CFP. FOV: 45 degrees — 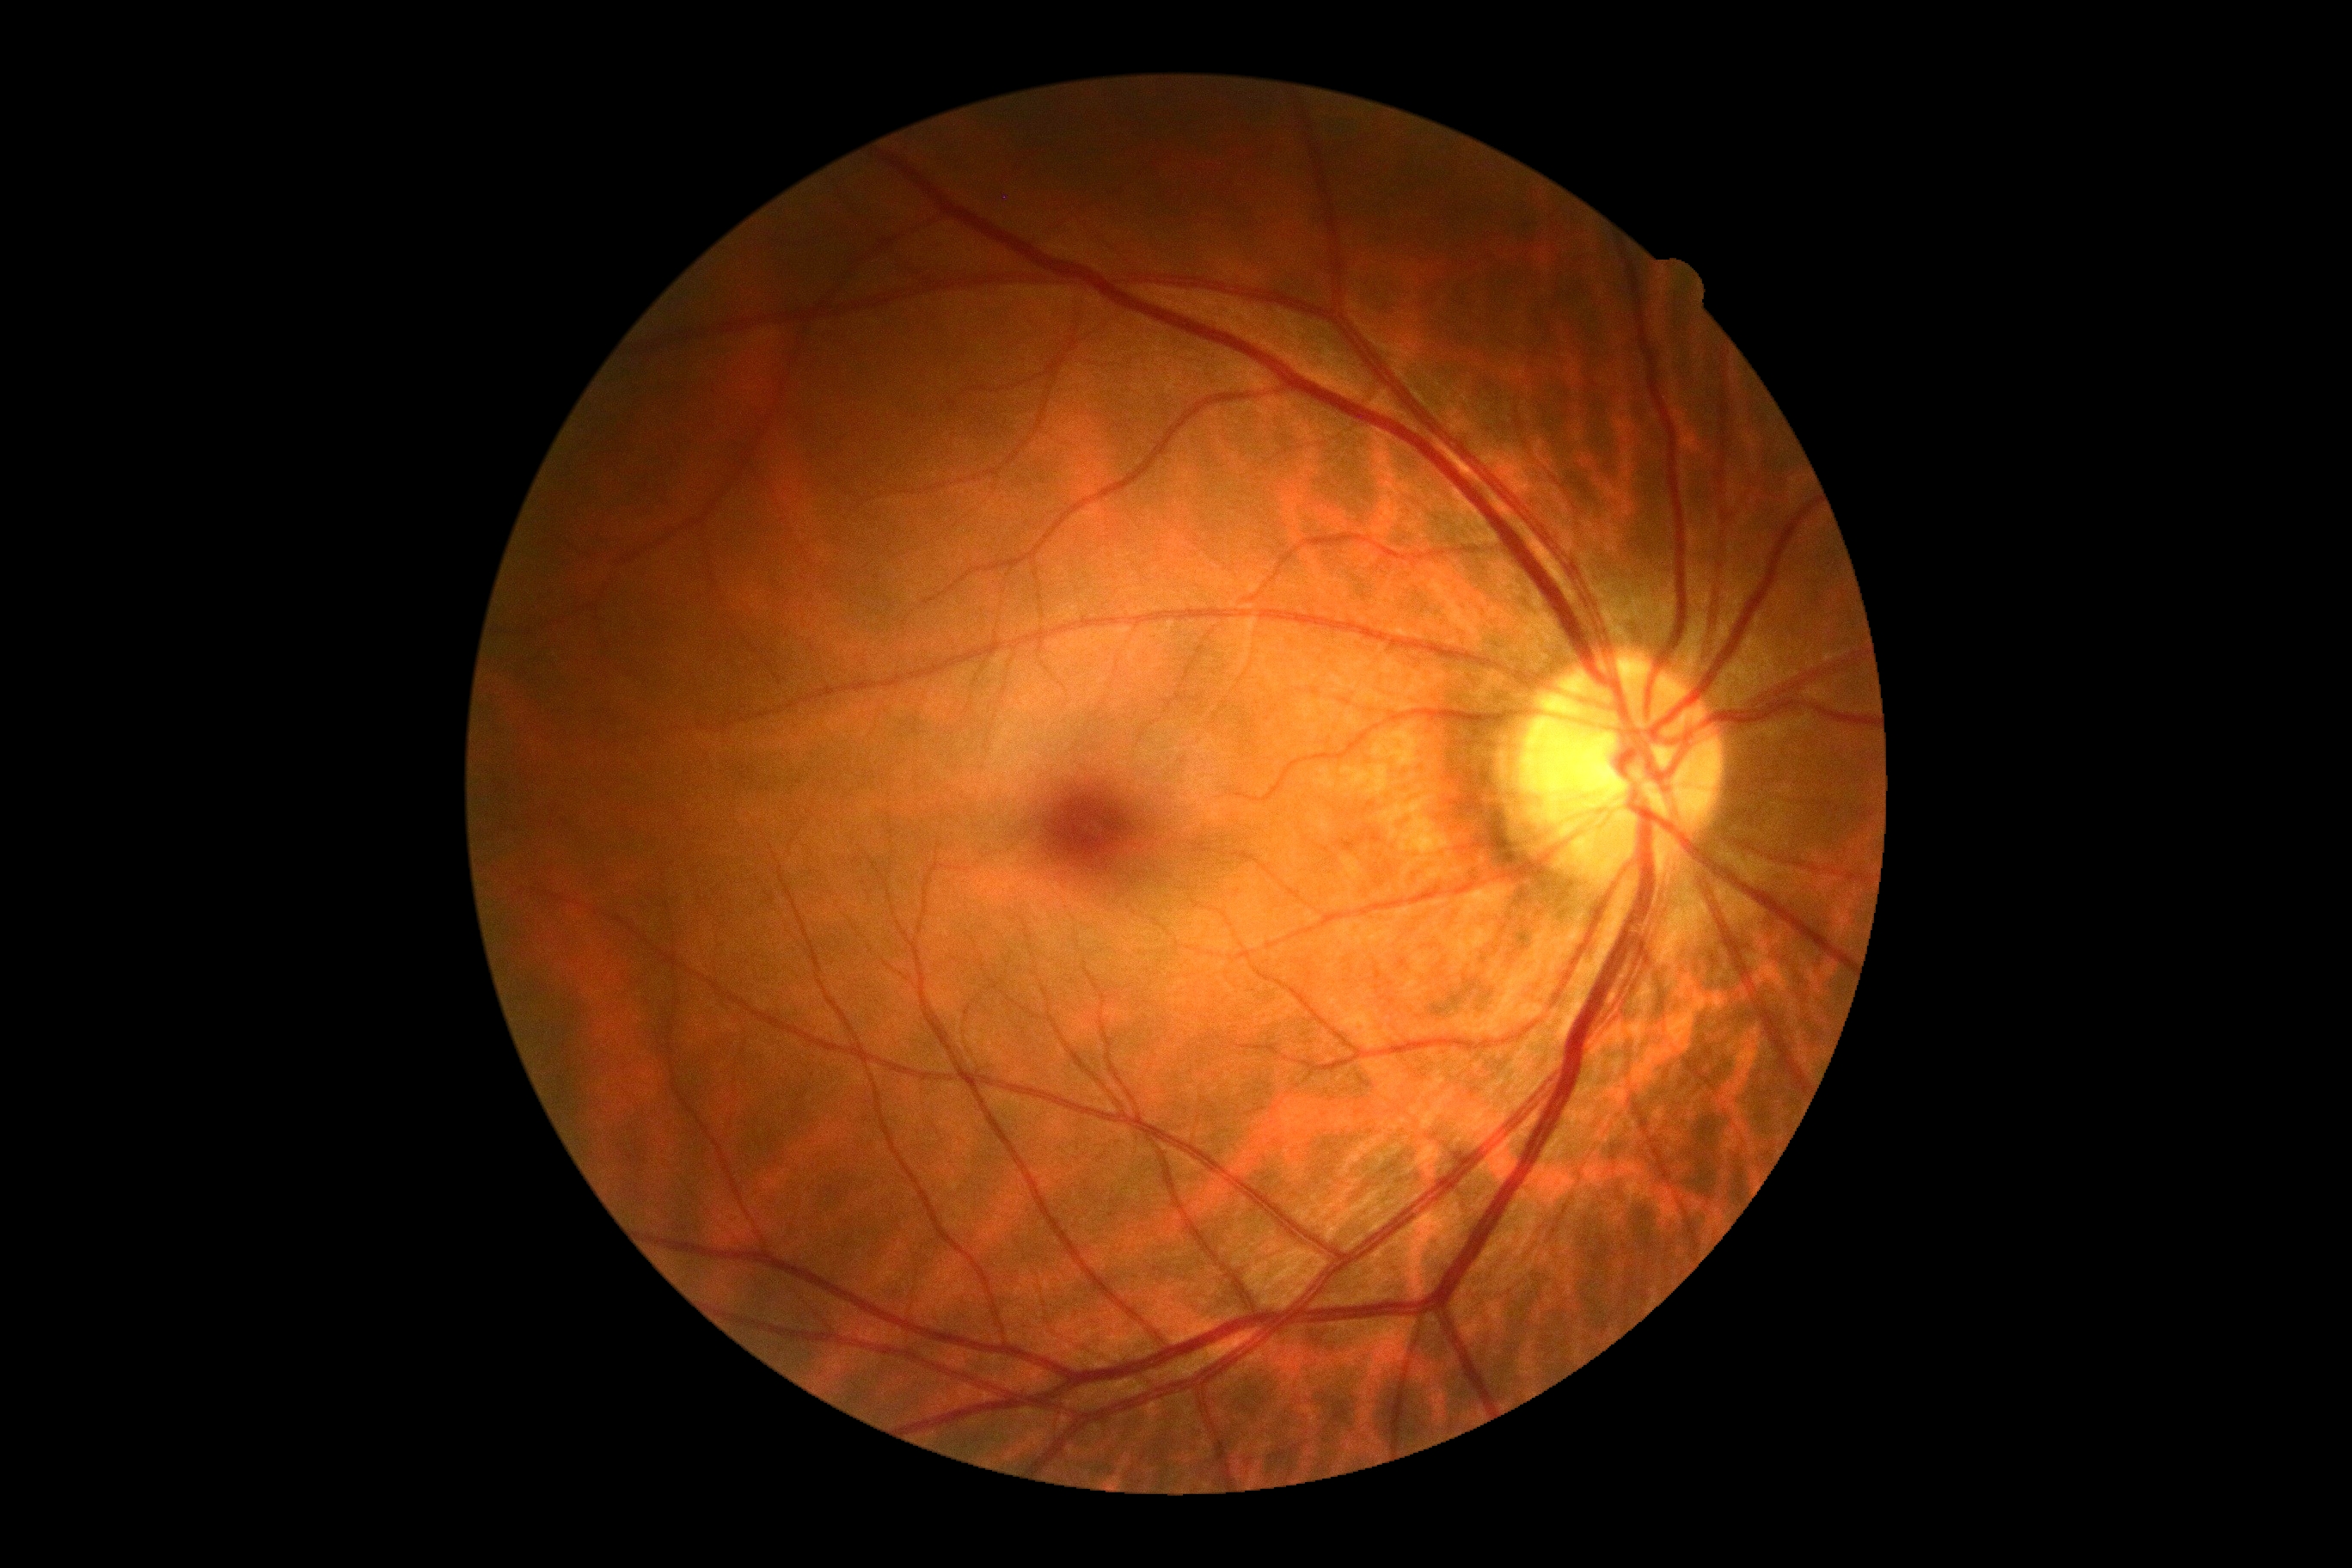
No apparent diabetic retinopathy. Diabetic retinopathy is 0/4.